Nonmydriatic fundus photograph, 848x848, Davis DR grading, acquired with a NIDEK AFC-230 — 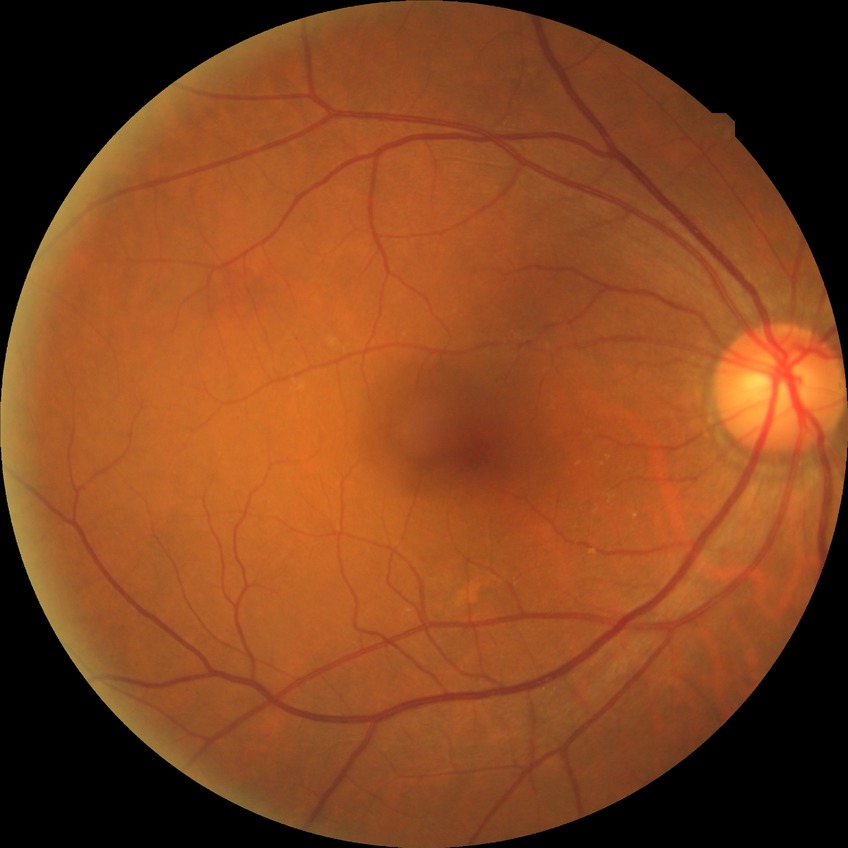 diabetic retinopathy (DR) = no diabetic retinopathy (NDR).